2048x1536 · CFP:
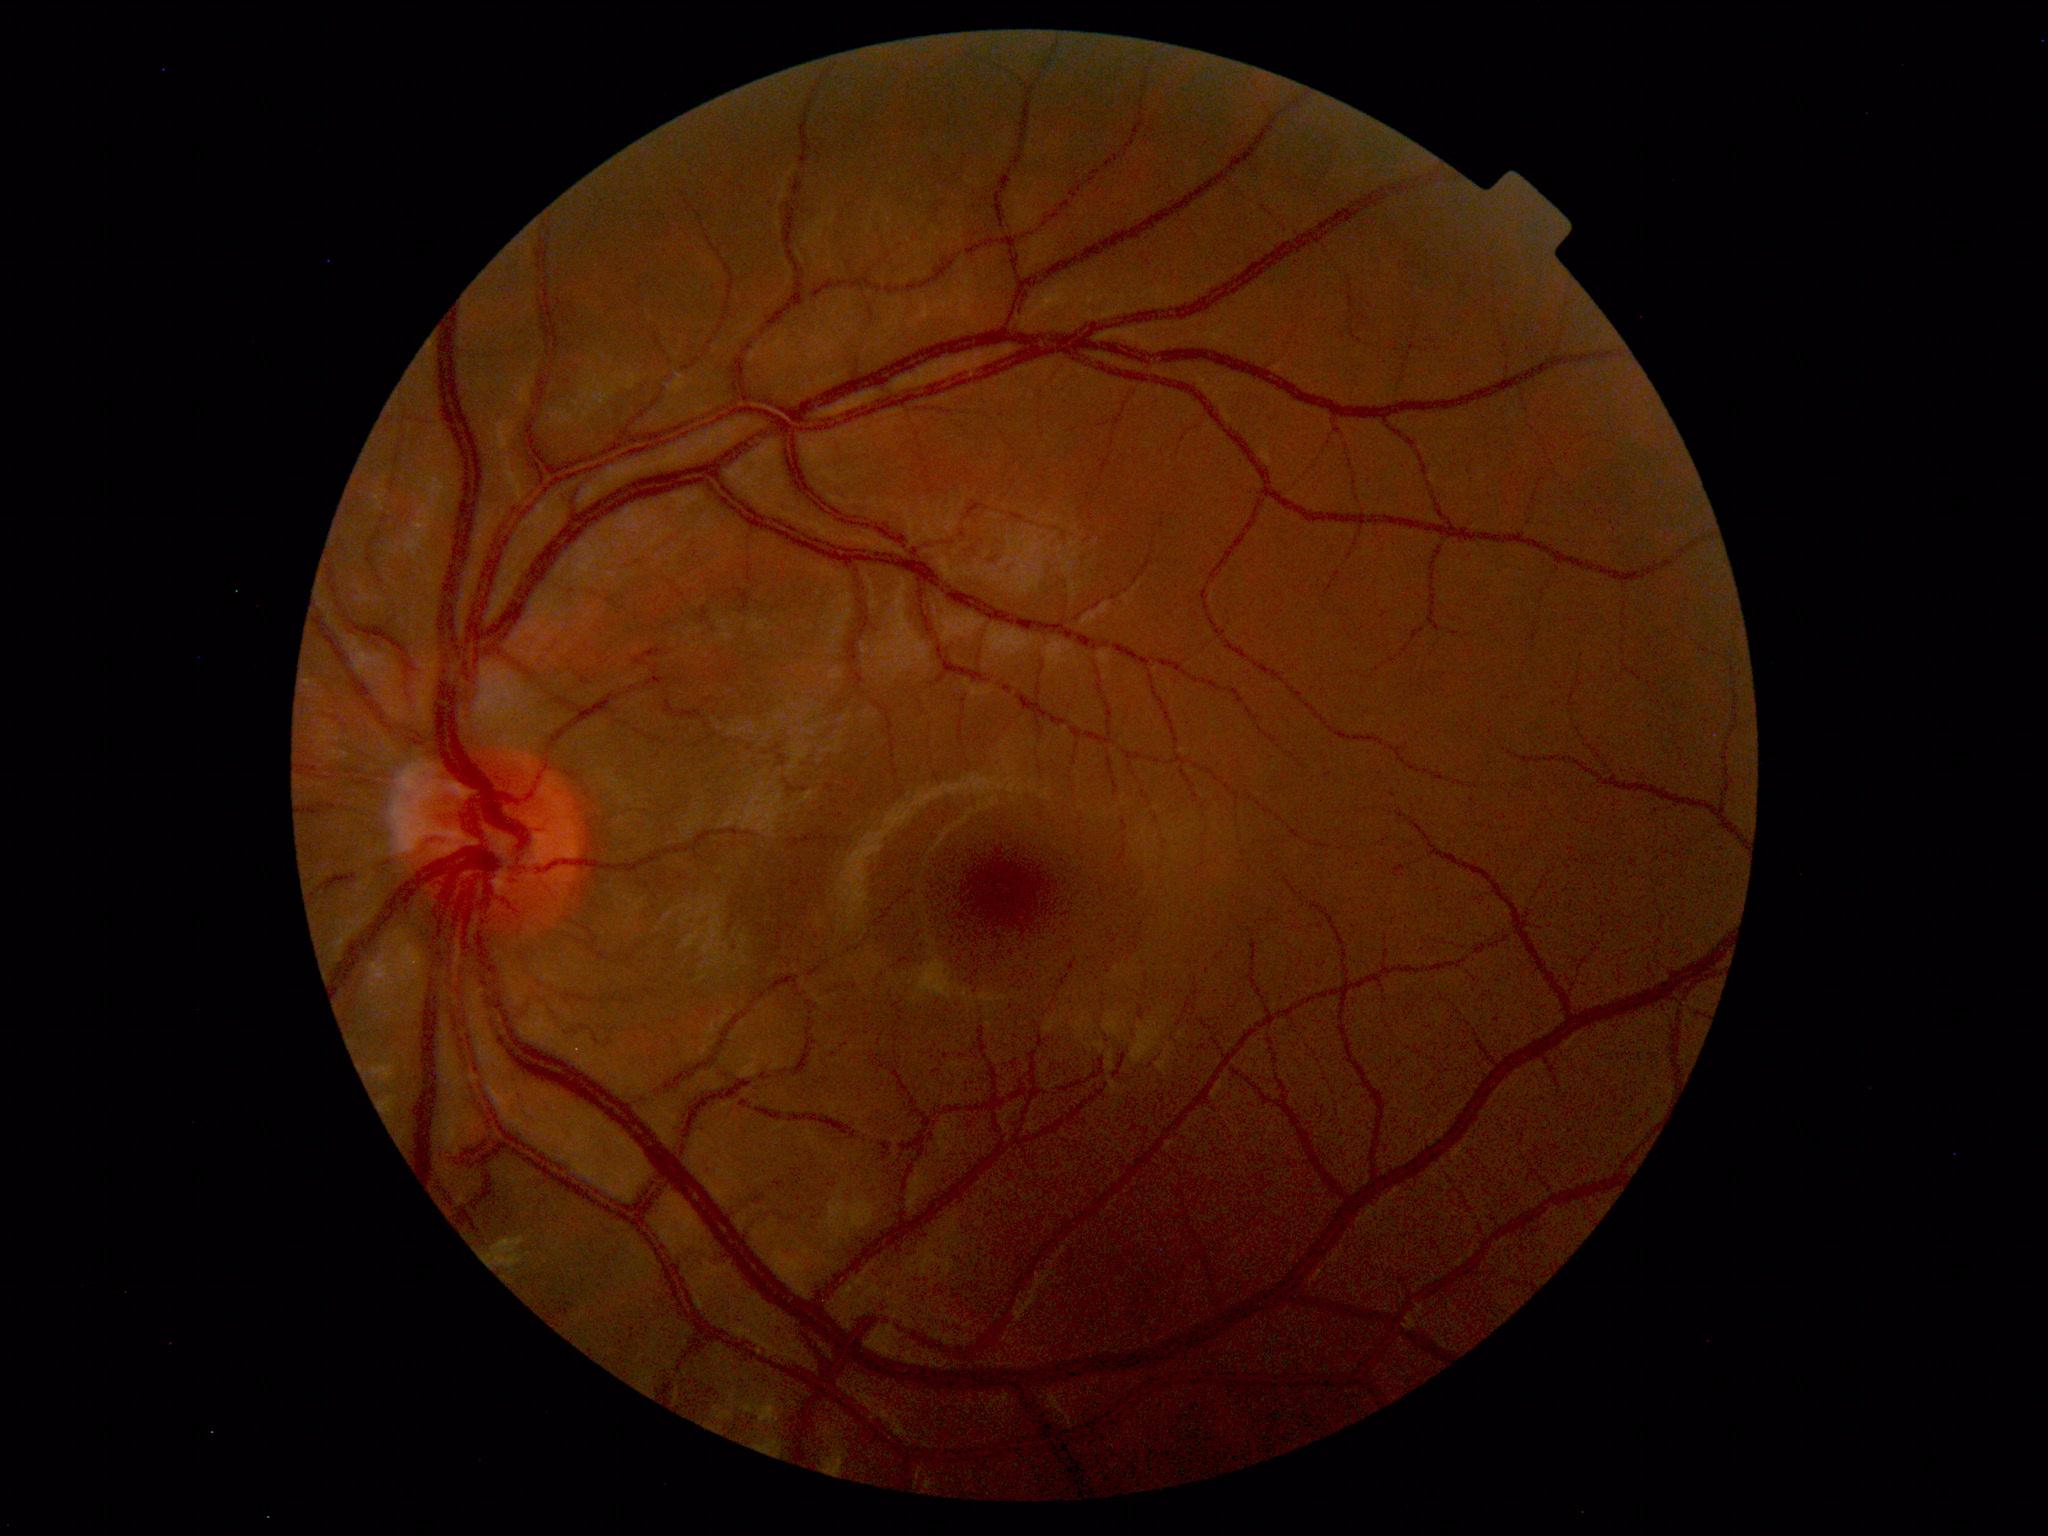

Impression: normal fundus.